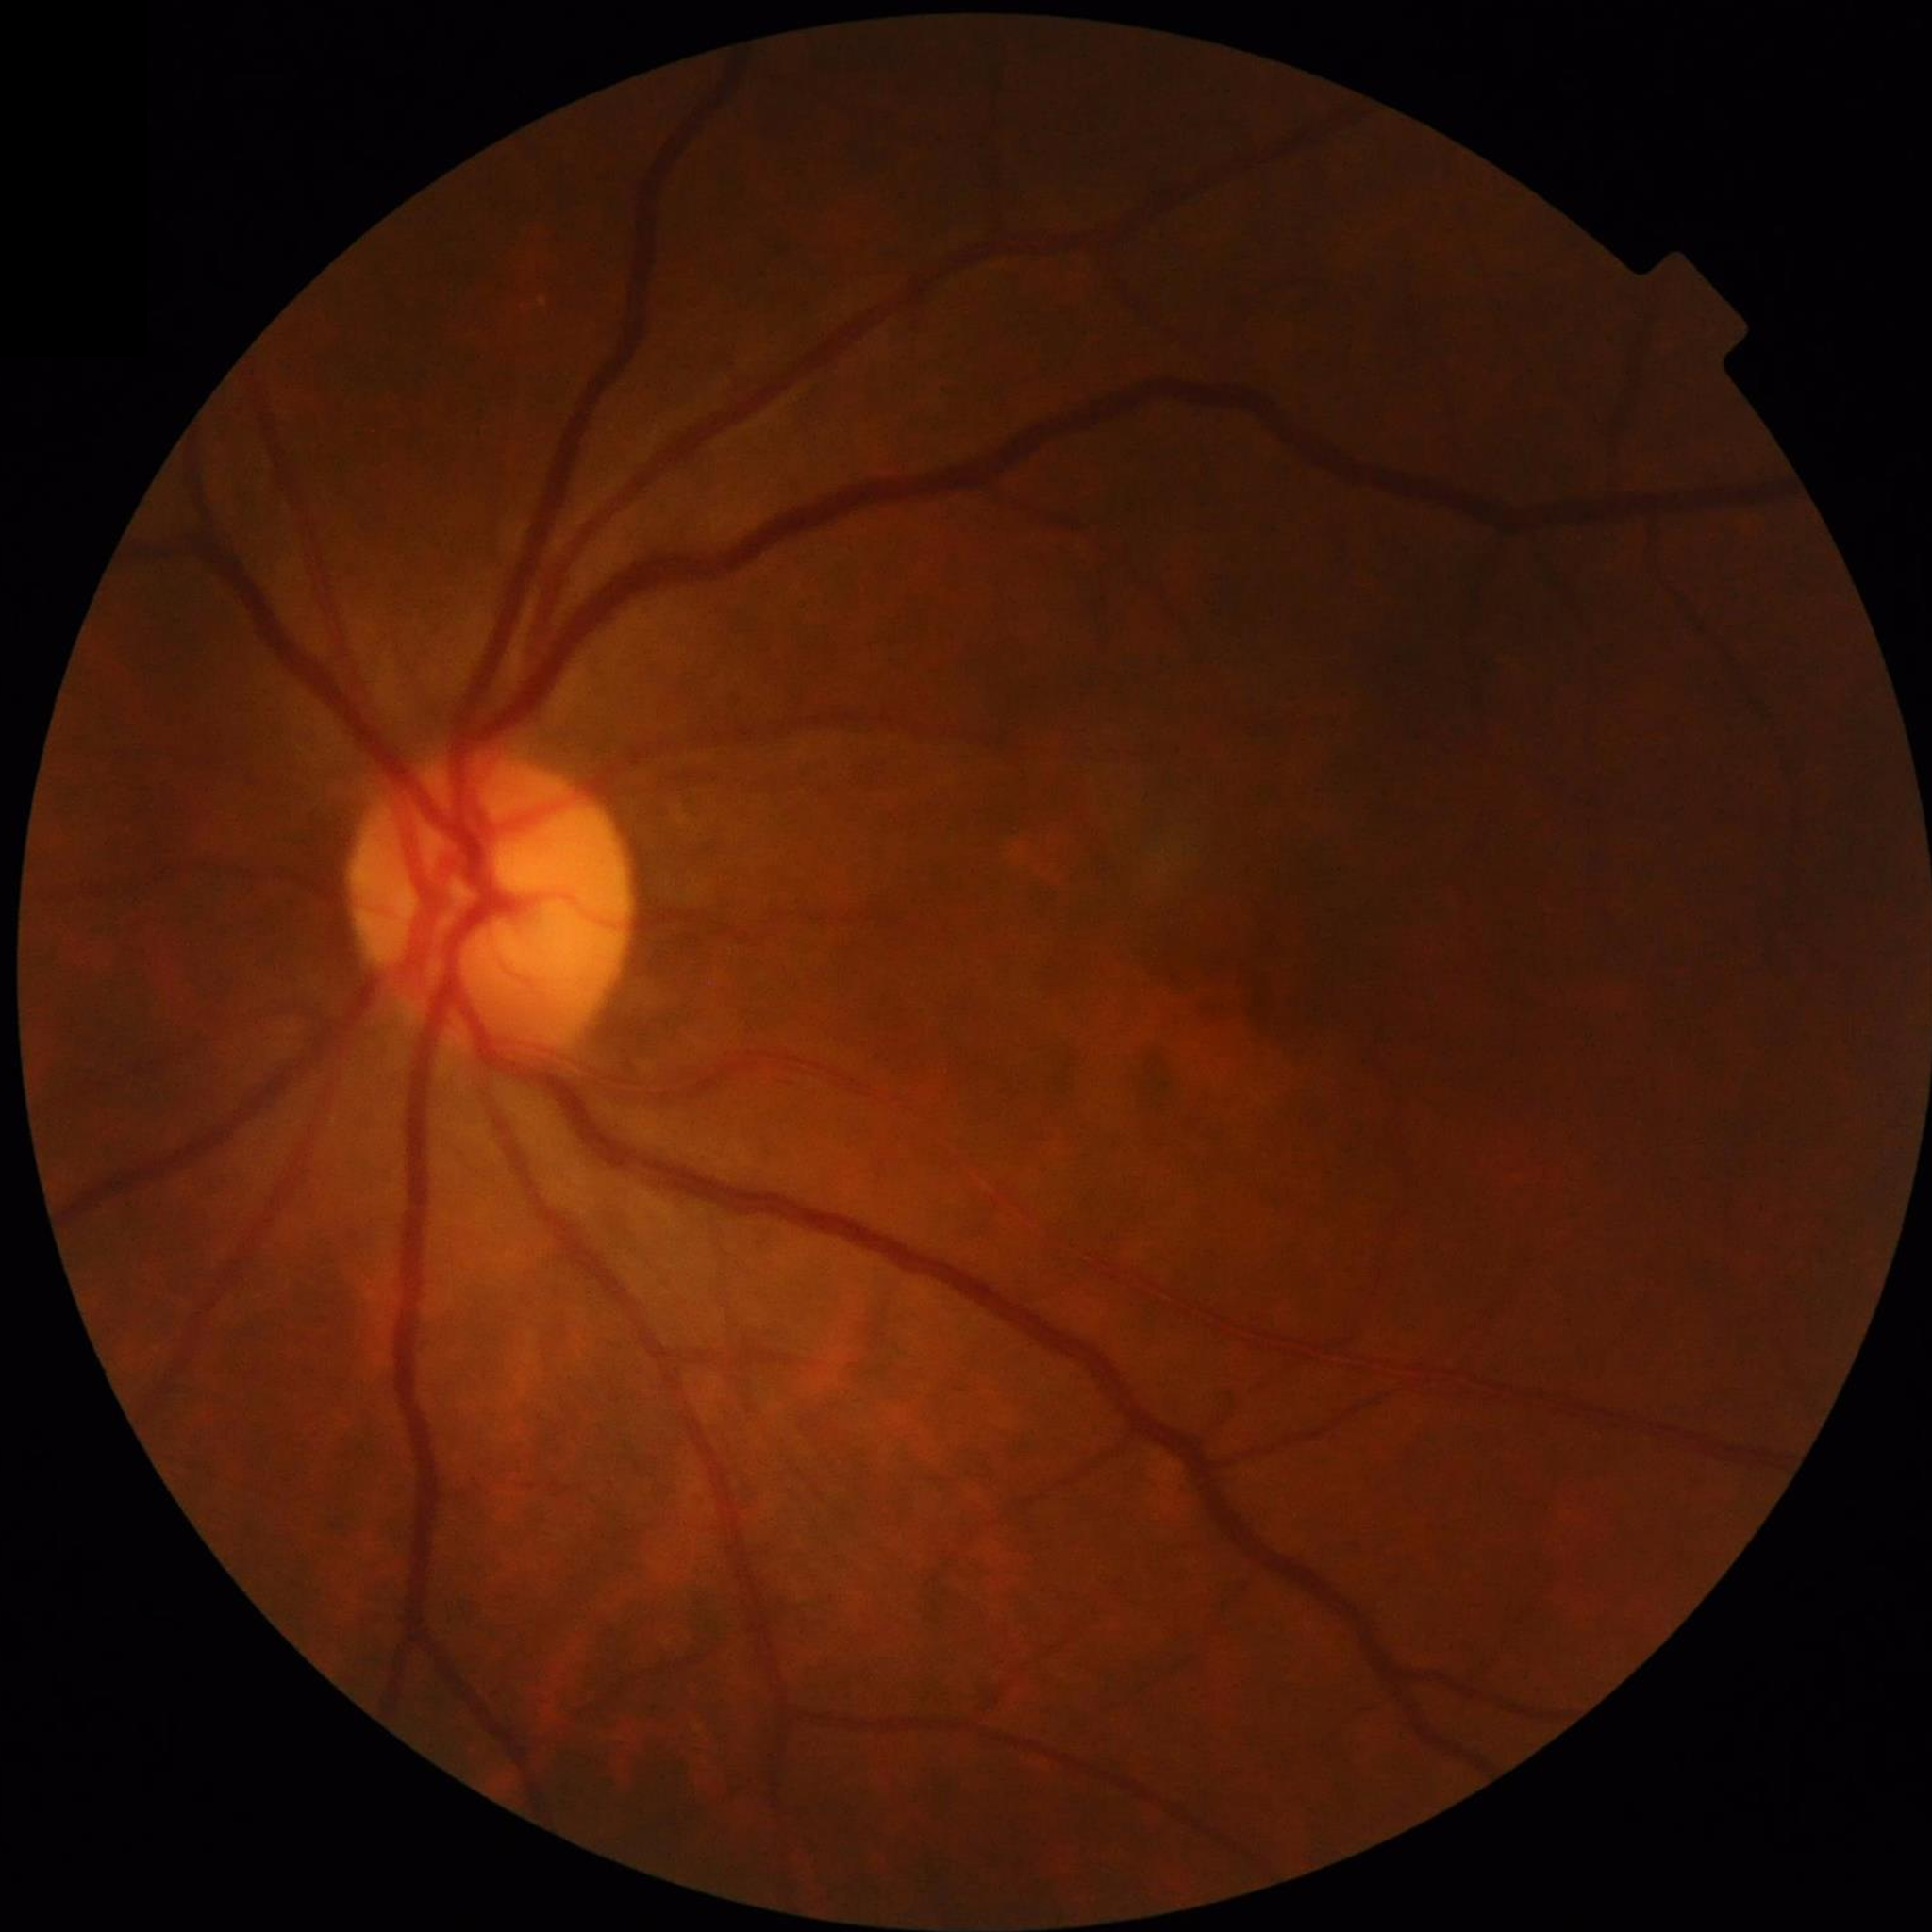

diagnosis: no AMD, diabetic retinopathy, or glaucoma